45-degree field of view:
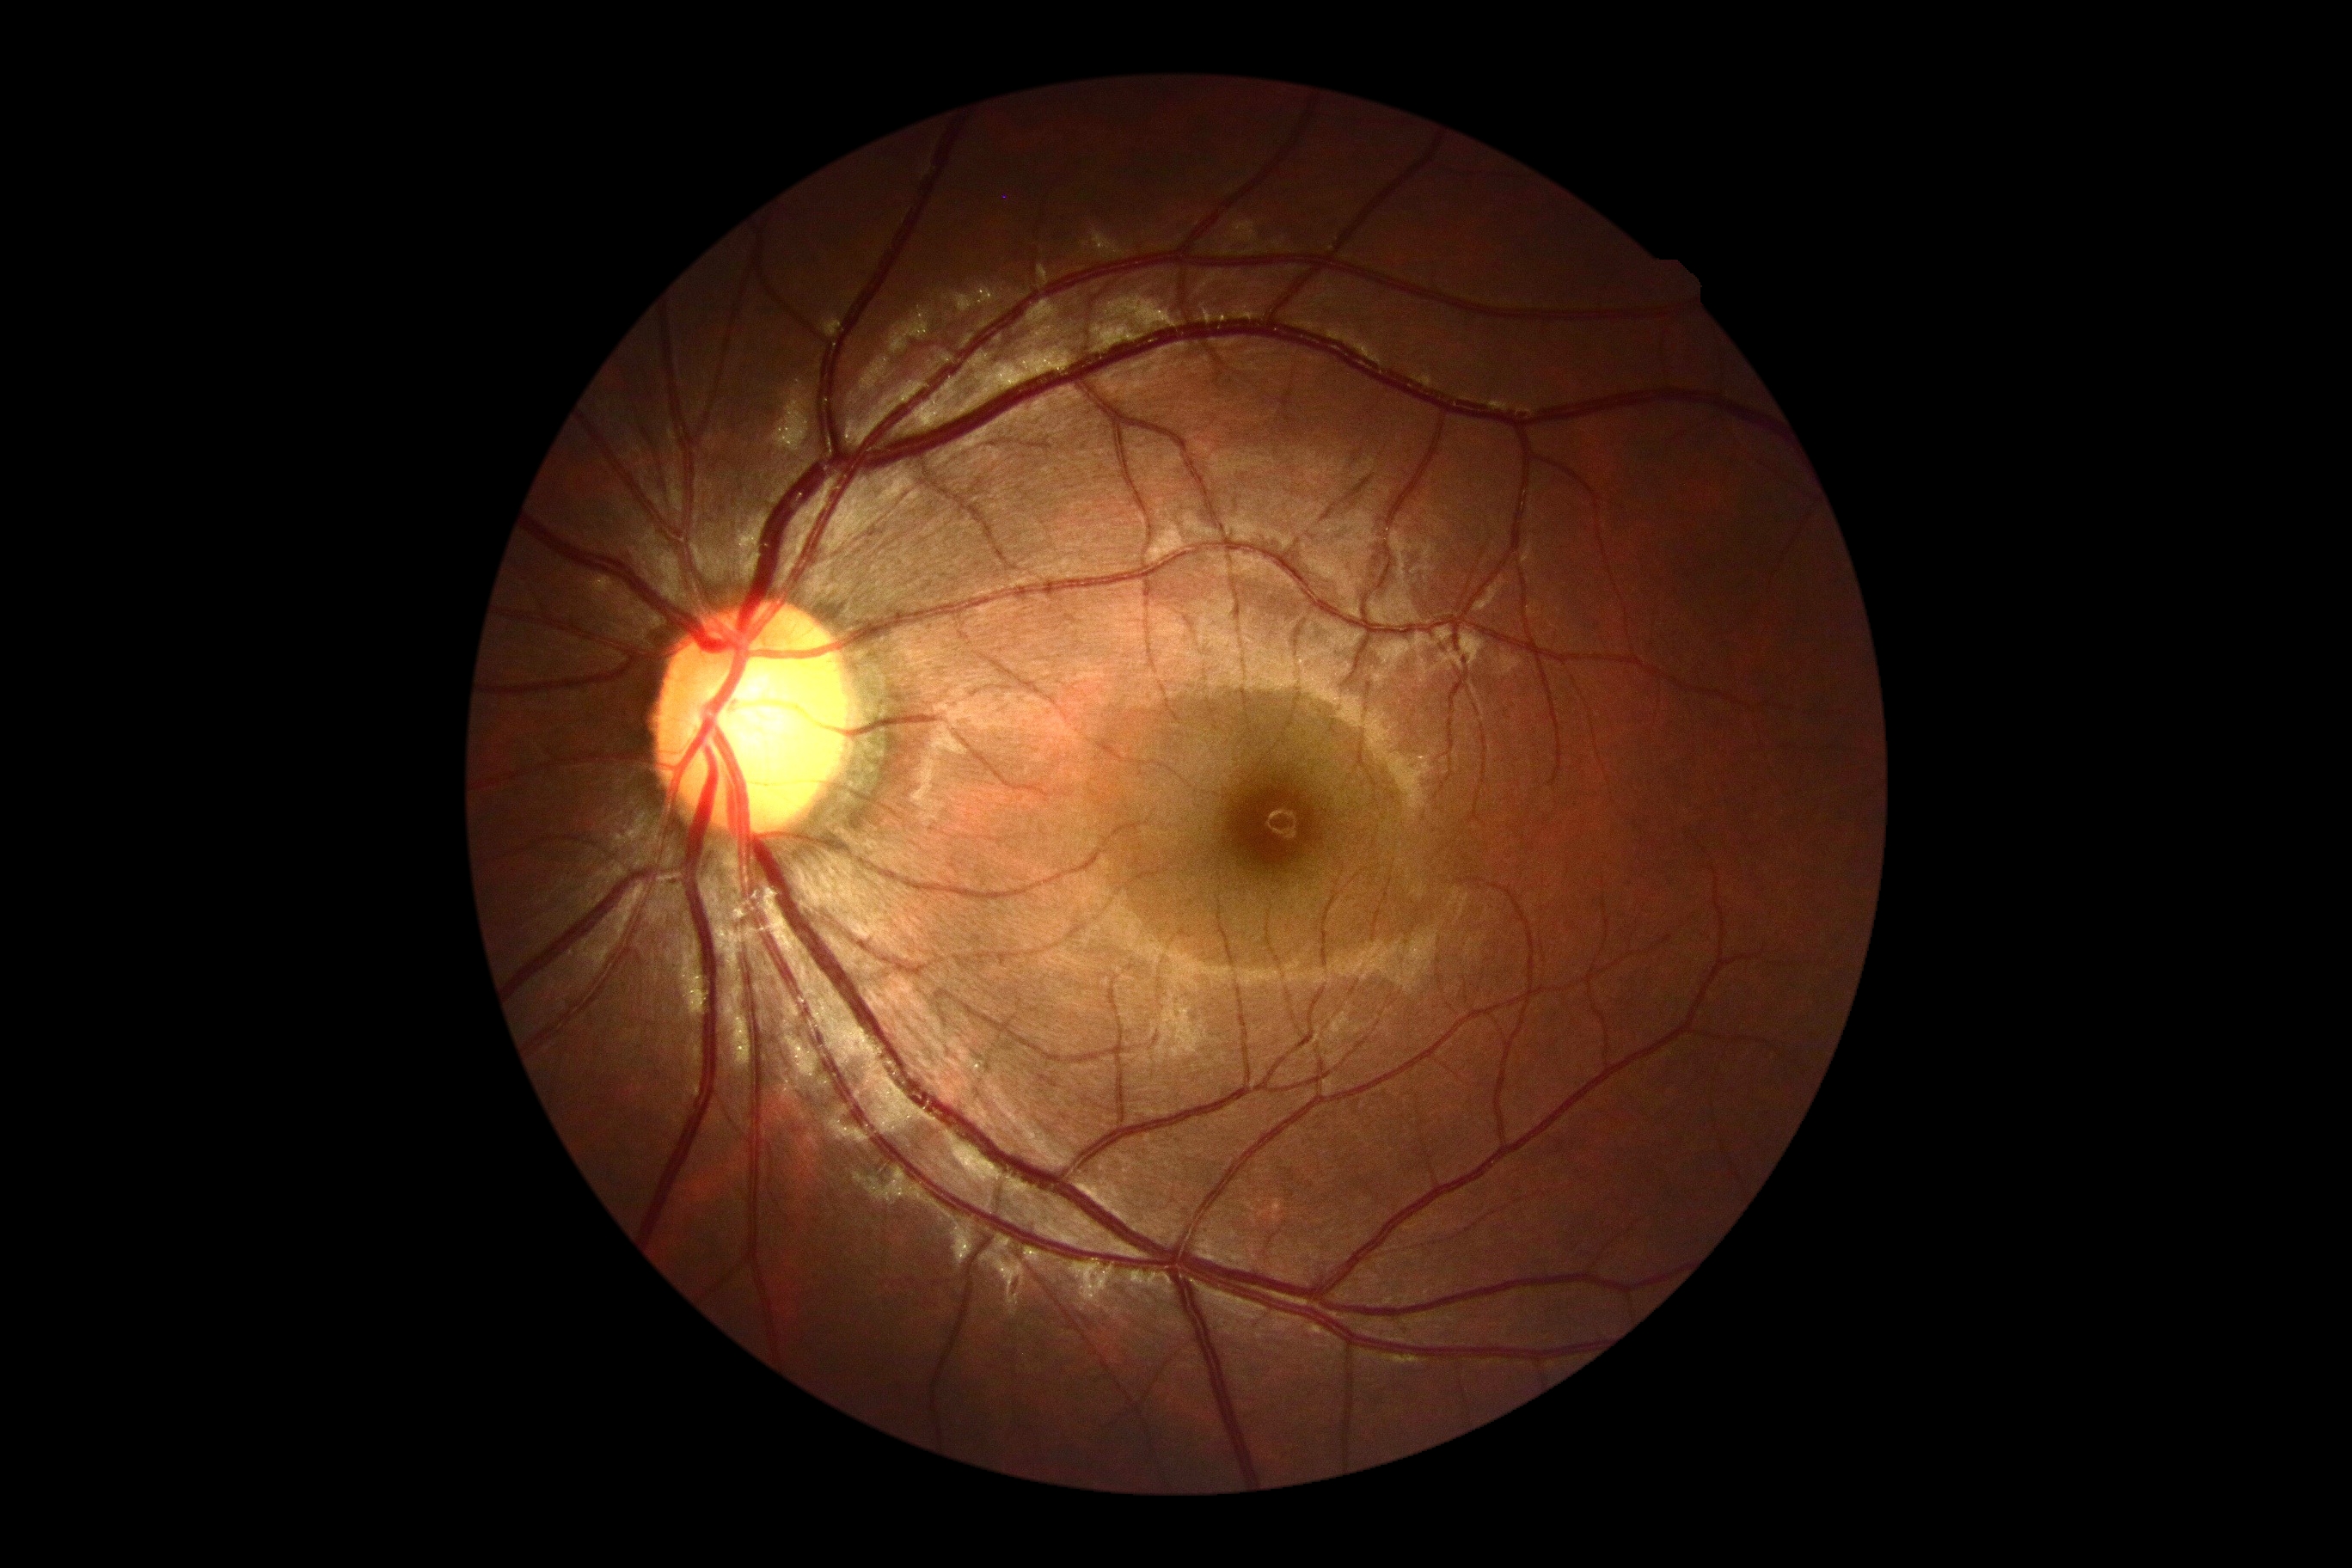 DR: no apparent retinopathy (grade 0).